1380x1382; 45° FOV; fundus photo: 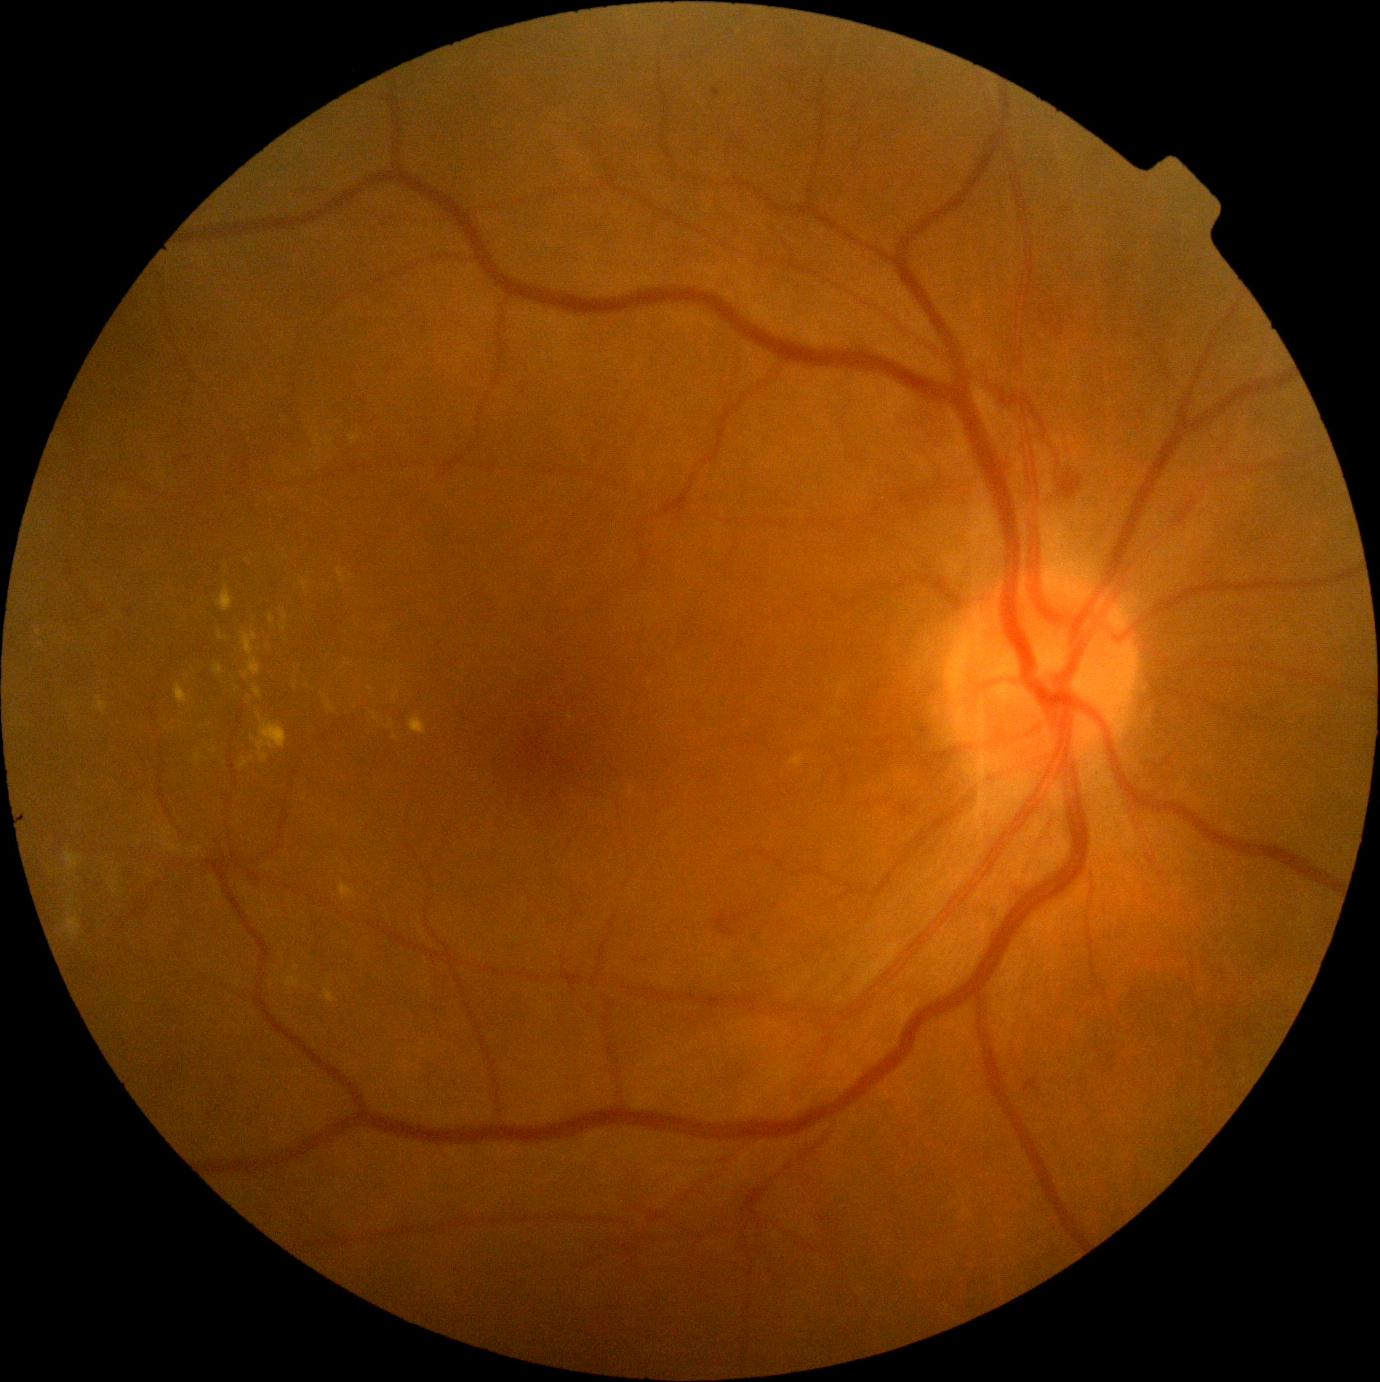

Retinopathy: 2 — more than just microaneurysms but less than severe NPDR
Lesions identified (partial list):
hard exudates (continued): bbox=(64, 915, 82, 939) | bbox=(287, 976, 300, 987) | bbox=(324, 990, 336, 1003) | bbox=(339, 884, 357, 900) | bbox=(214, 664, 223, 675) | bbox=(303, 578, 309, 590) | bbox=(282, 610, 288, 624) | bbox=(292, 680, 299, 688) | bbox=(373, 714, 379, 722) | bbox=(253, 686, 262, 699) | bbox=(66, 851, 82, 872) | bbox=(392, 693, 398, 702) | bbox=(242, 632, 261, 680)
Additional small hard exudates near [x=213, y=750] | [x=356, y=707] | [x=248, y=561] | [x=297, y=968] | [x=236, y=690] | [x=371, y=689]